Acquired on the Phoenix ICON. Wide-field fundus photograph from neonatal ROP screening
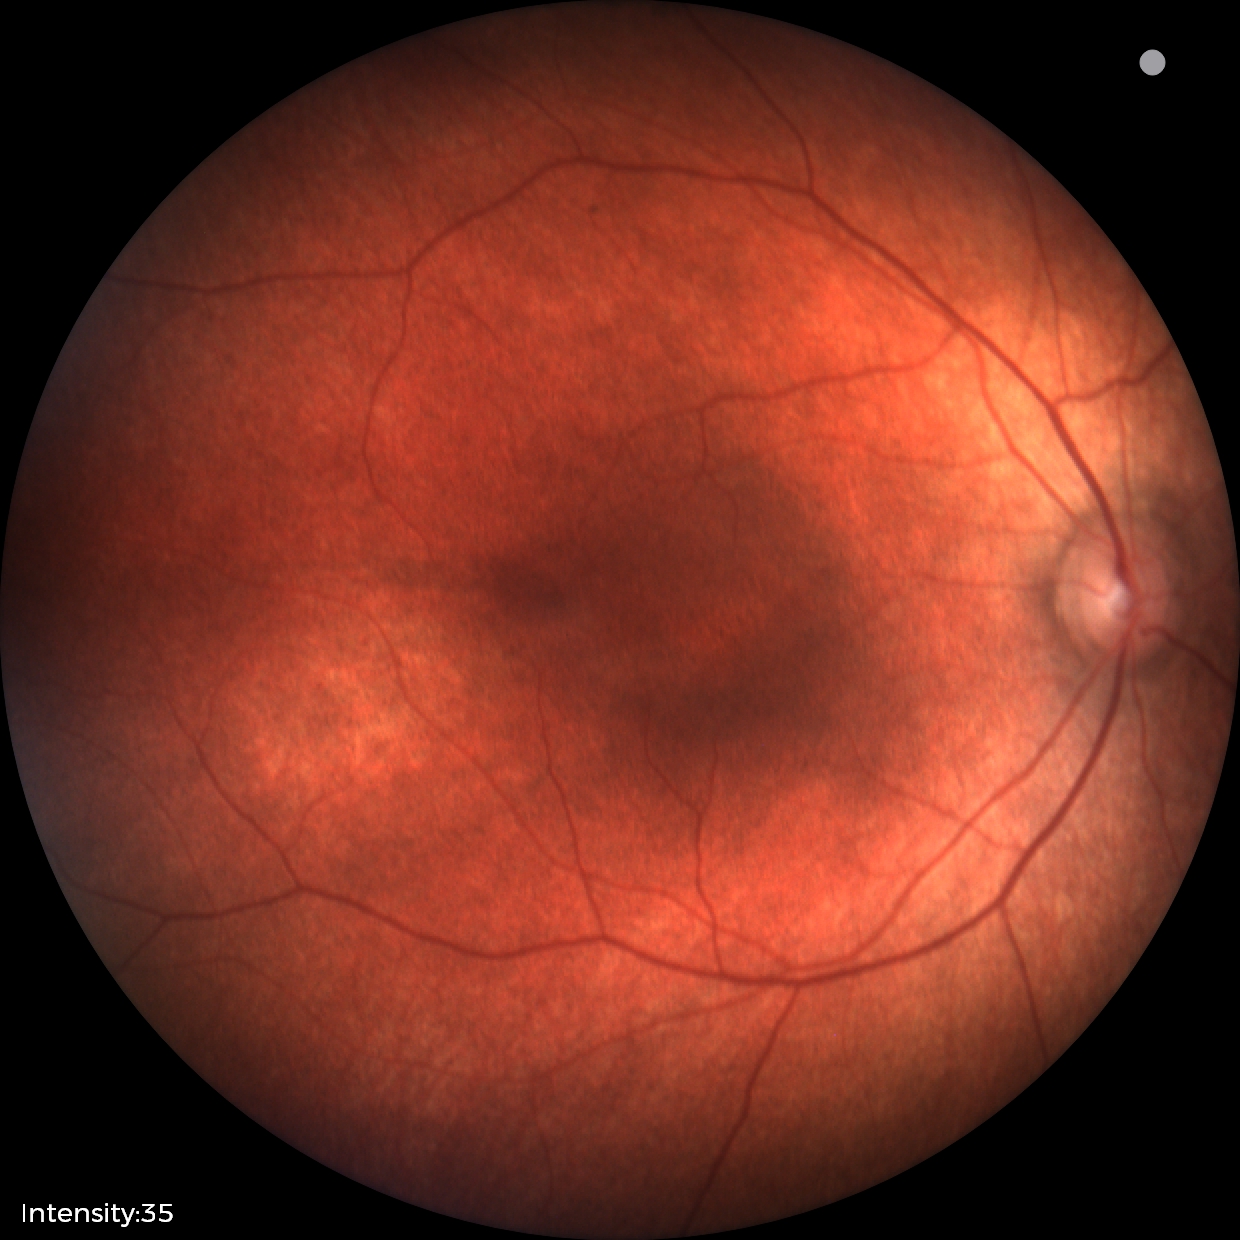
Screening diagnosis: physiological appearance.